Non-mydriatic fundus camera.
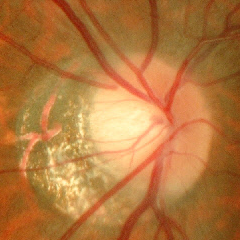

Optic disc appearance consistent with no glaucomatous changes.